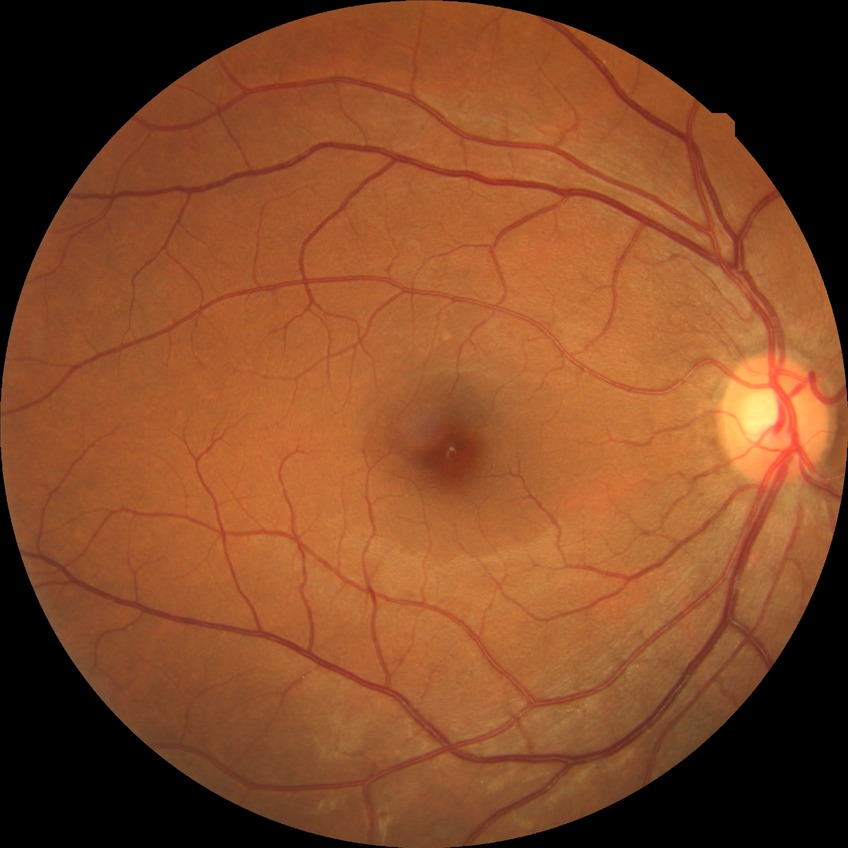
Diabetic retinopathy (DR) is no diabetic retinopathy (NDR).